Color fundus photograph:
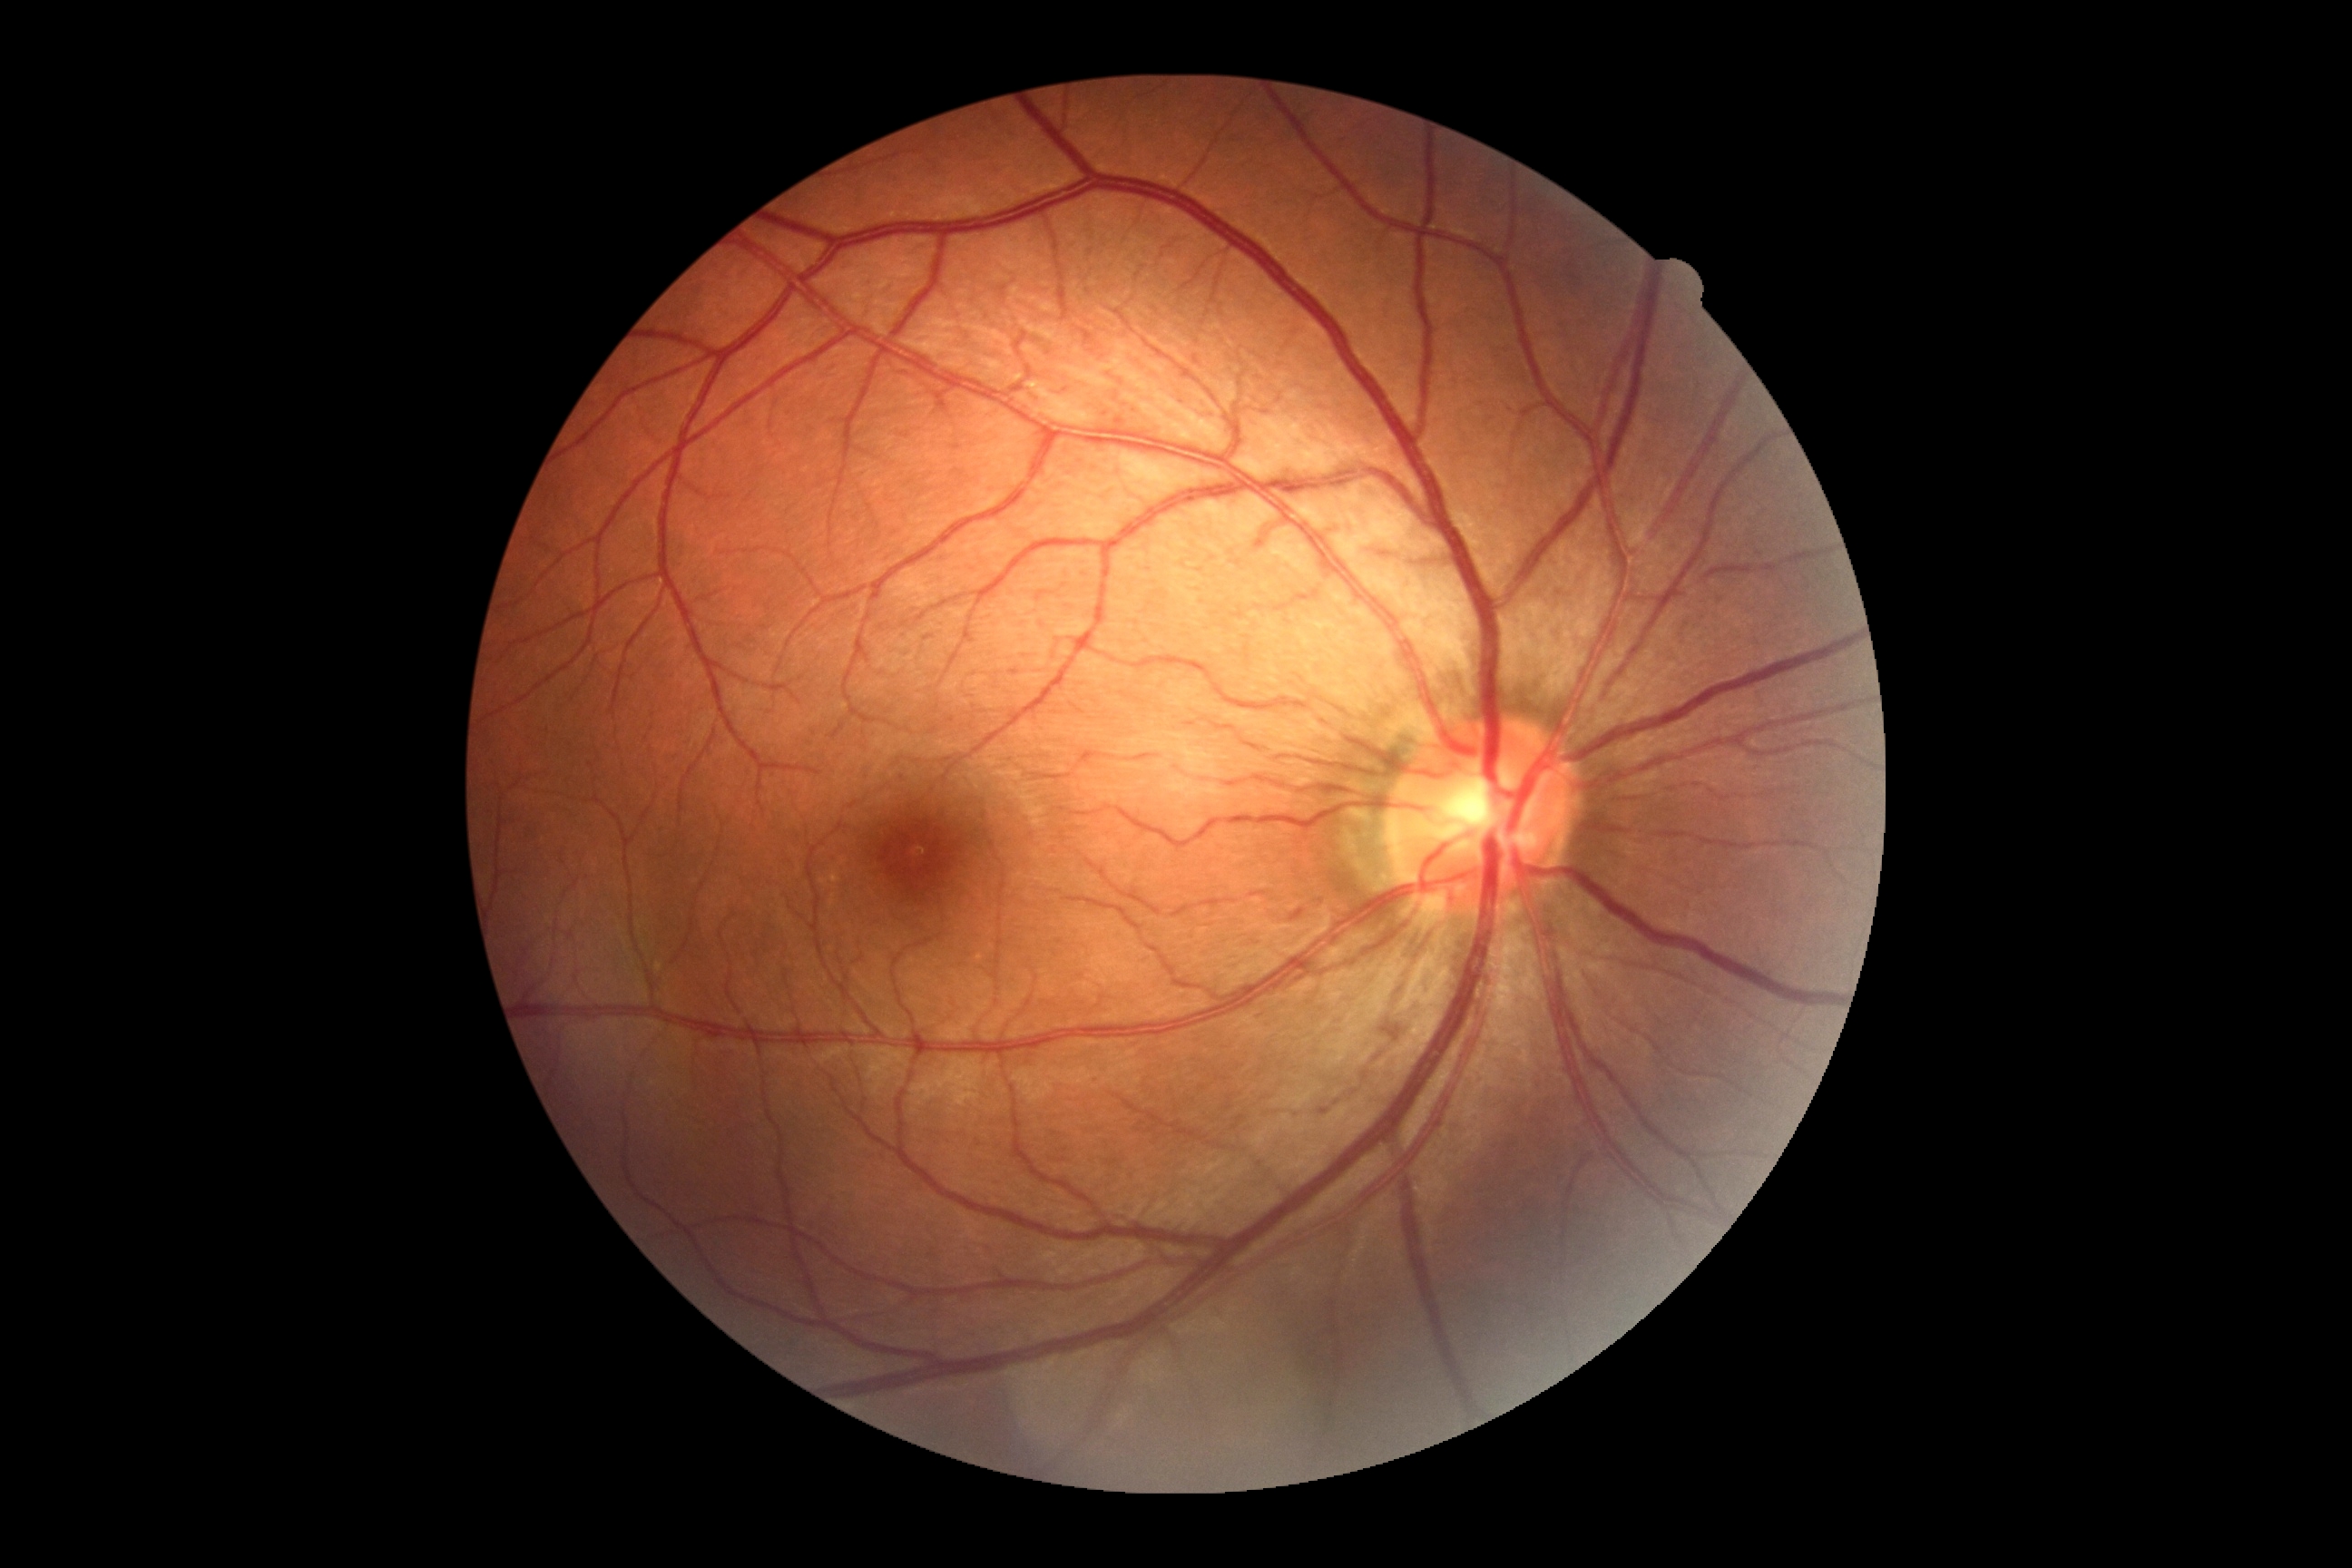
DR is 0 — no visible signs of diabetic retinopathy.